Color fundus image. 2089 by 1764 pixels:
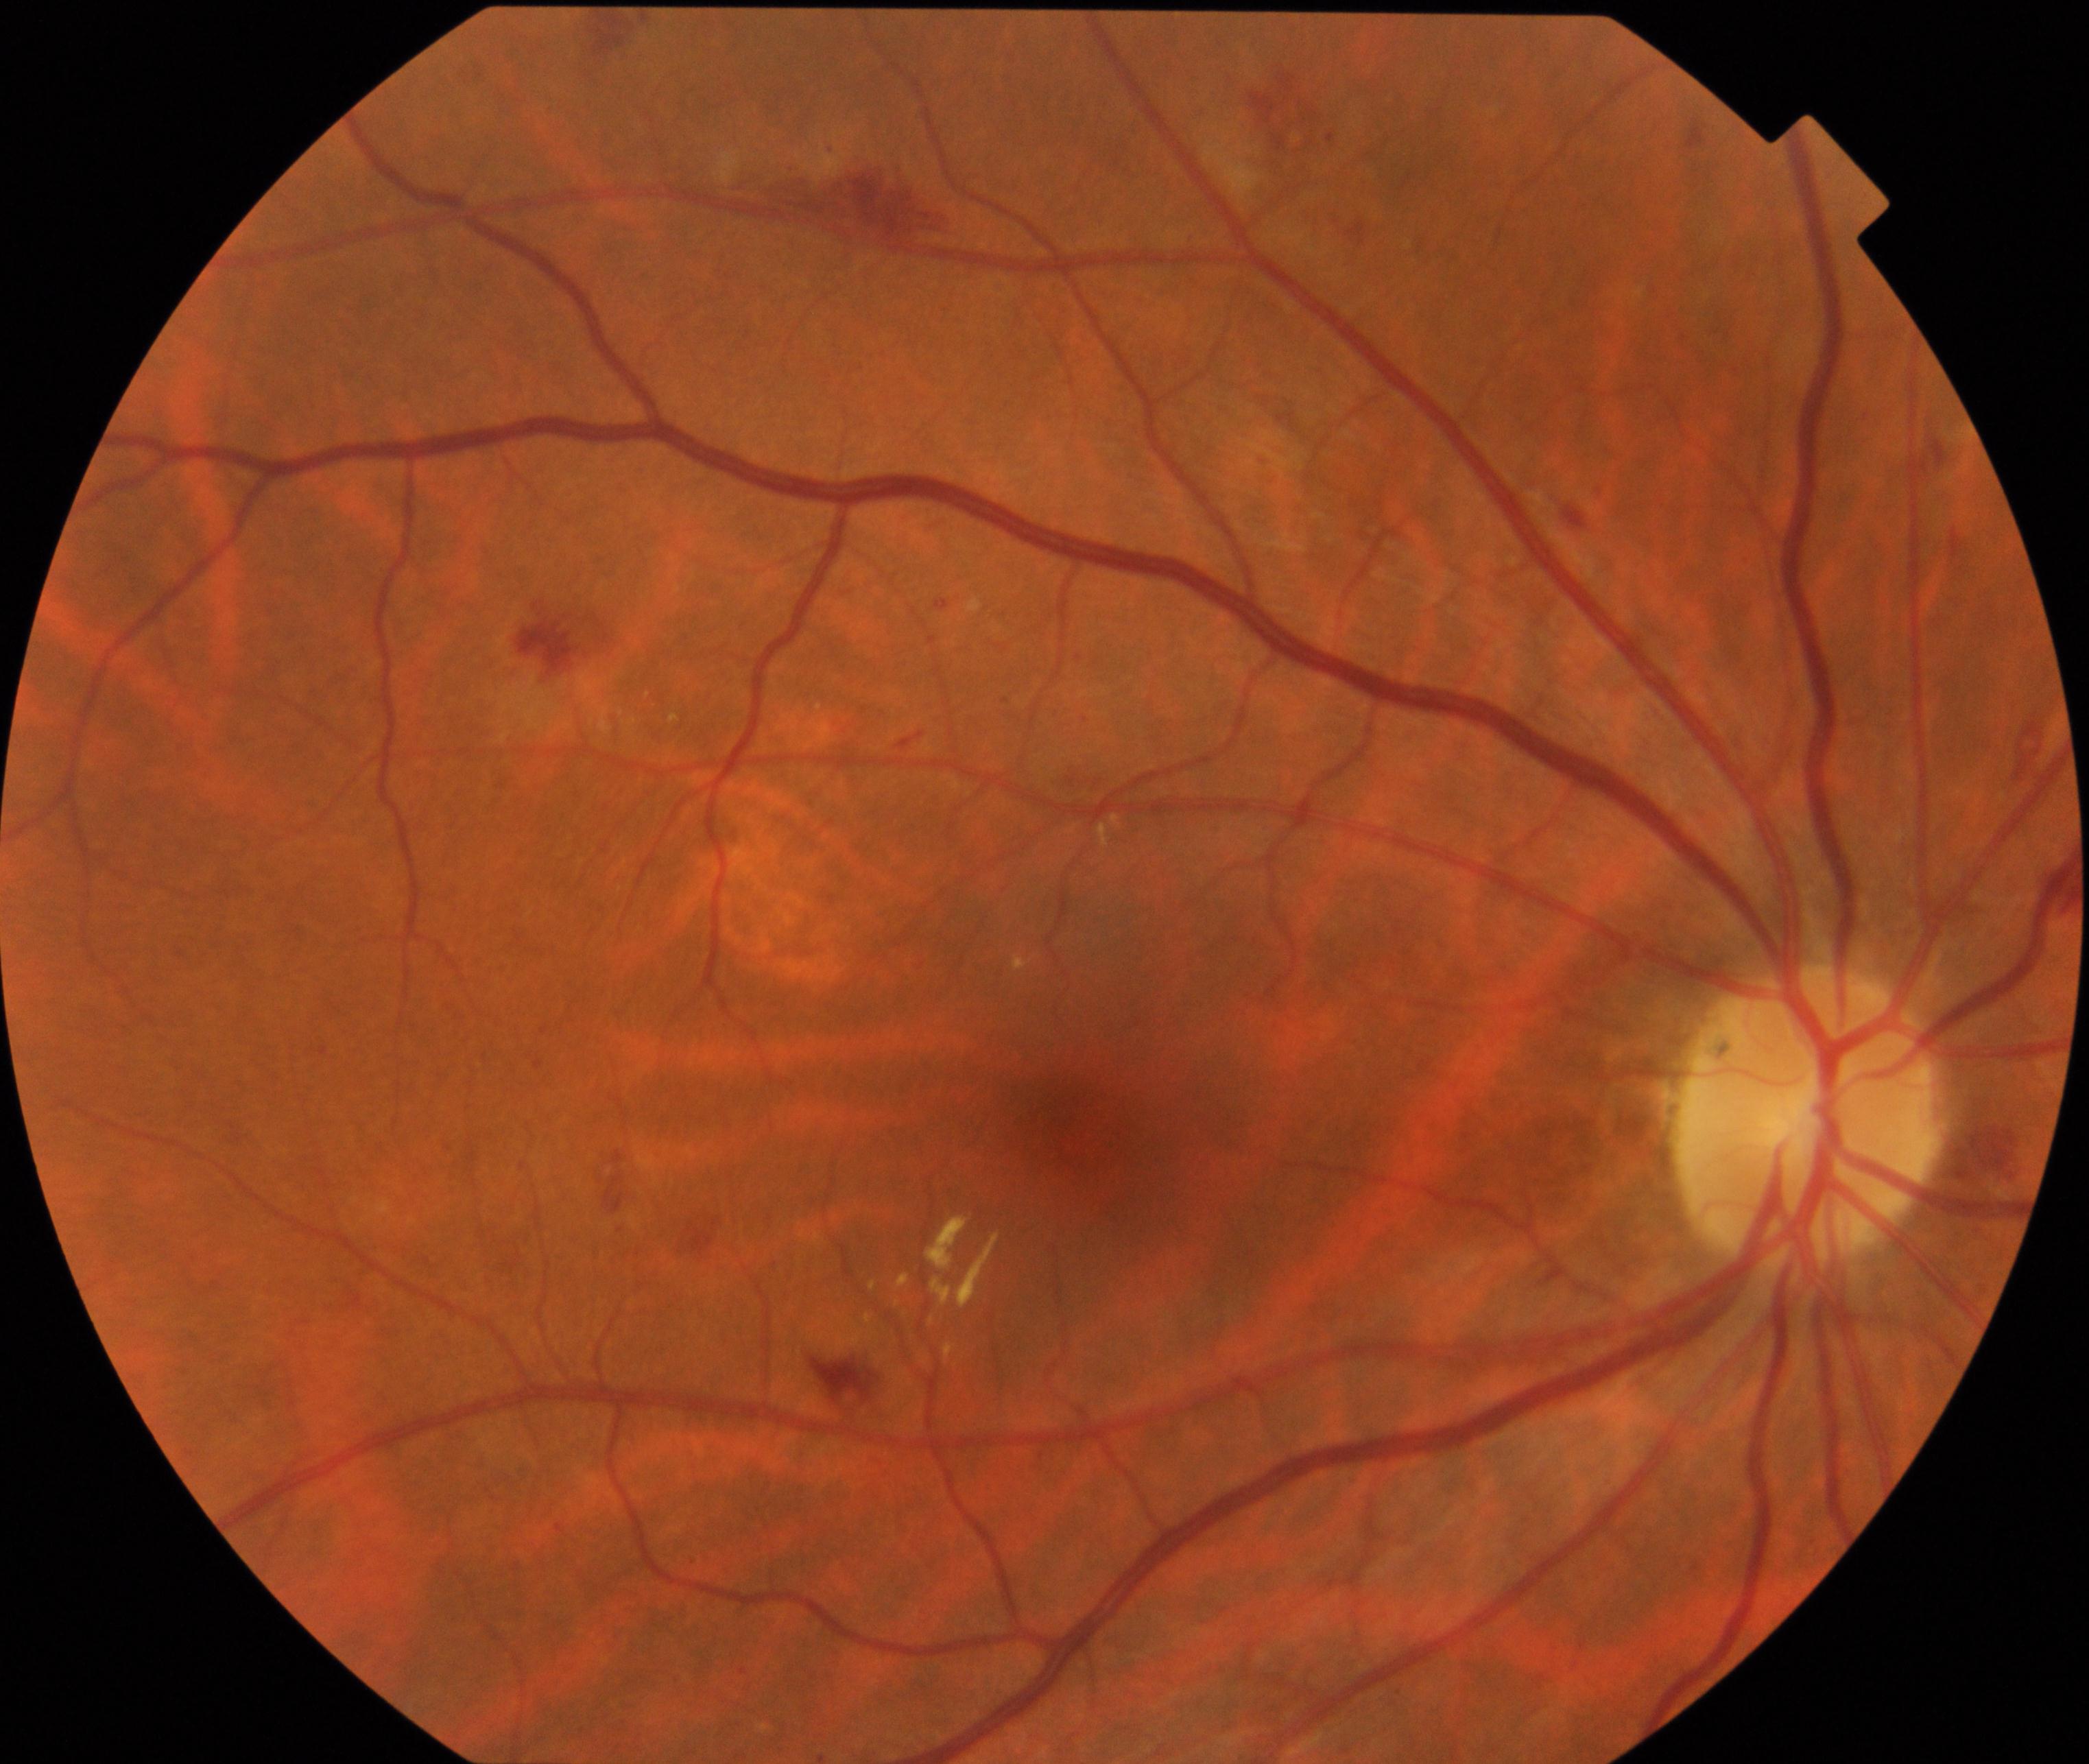
Findings consistent with moderate non-proliferative diabetic retinopathy.